Nonmydriatic. Acquired with a NIDEK AFC-230. Graded on the modified Davis scale. Retinal fundus photograph: 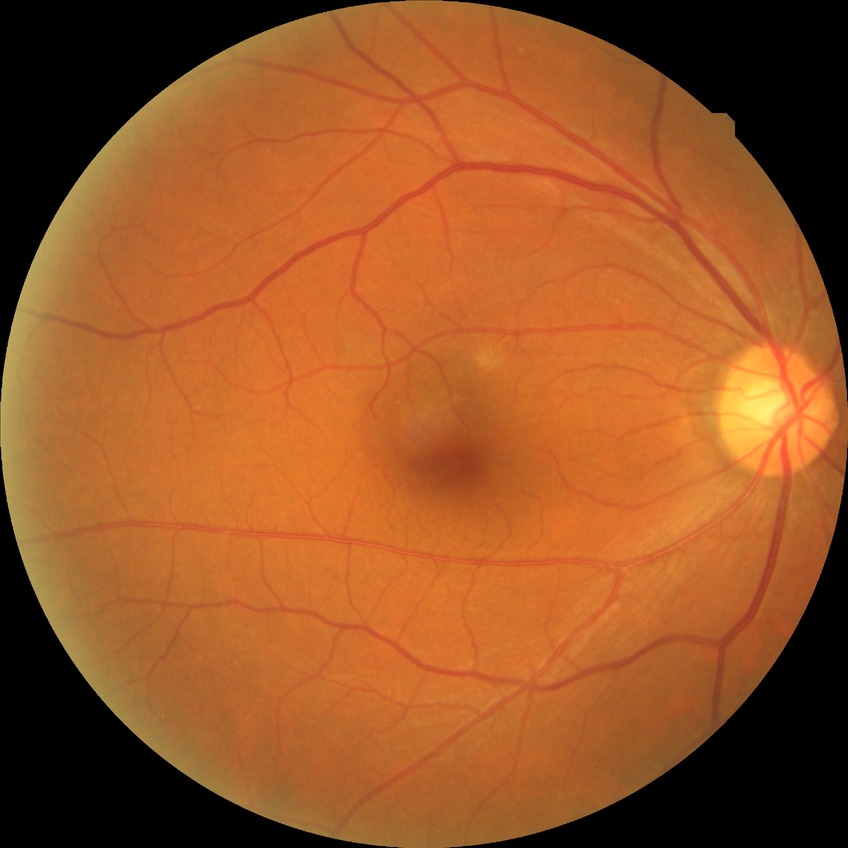 Modified Davis grading is no diabetic retinopathy.